Fundus photo — 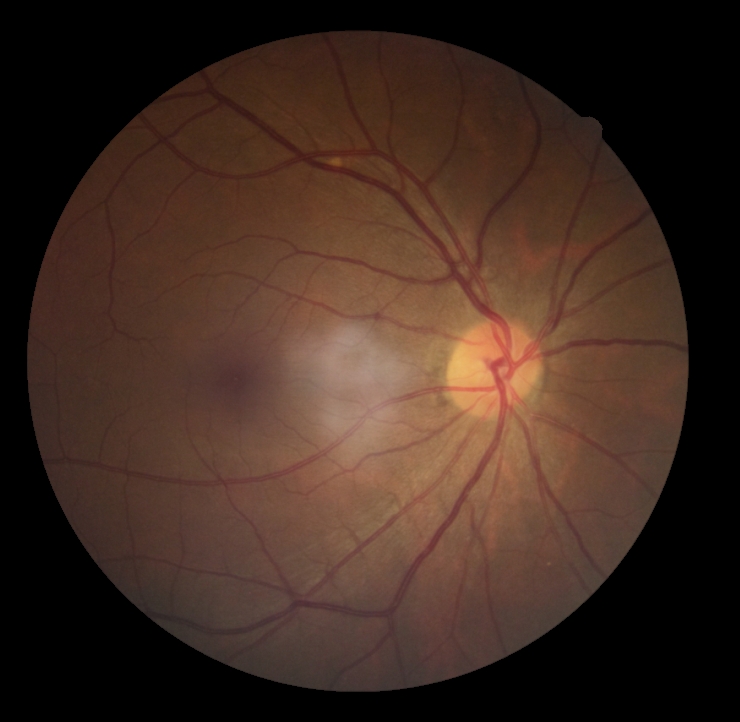
Diabetic retinopathy (DR) is 0.
No DR findings.